1924 x 1556 pixels, ultra-widefield fundus mosaic.
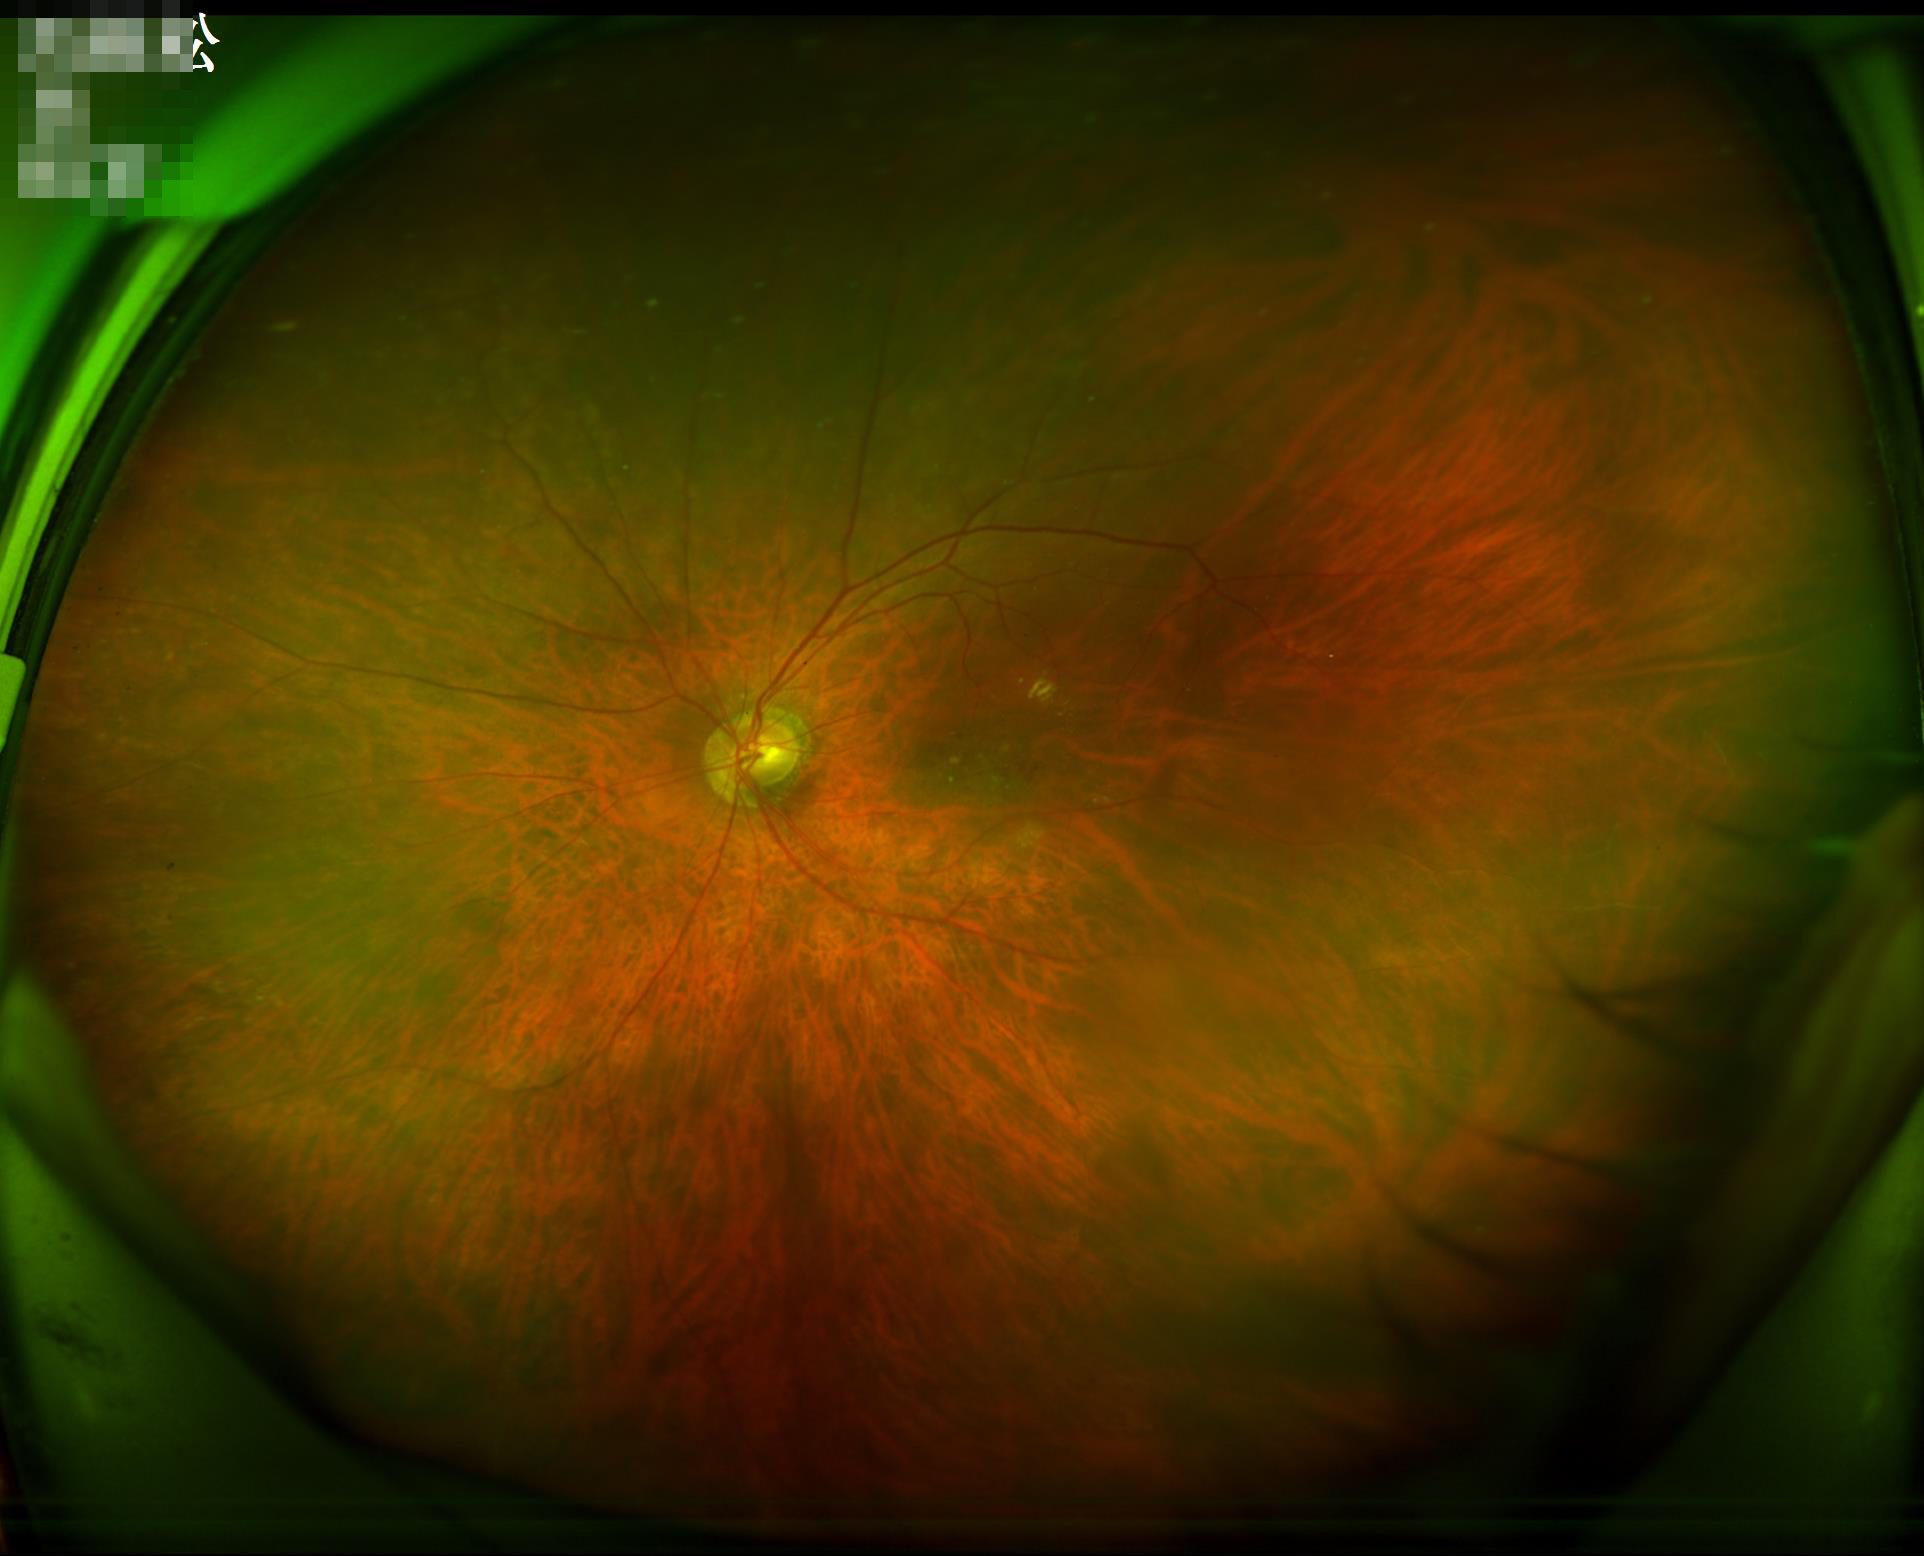 Overall image quality: good, gradable; Contrast: good dynamic range.